Davis DR grading: 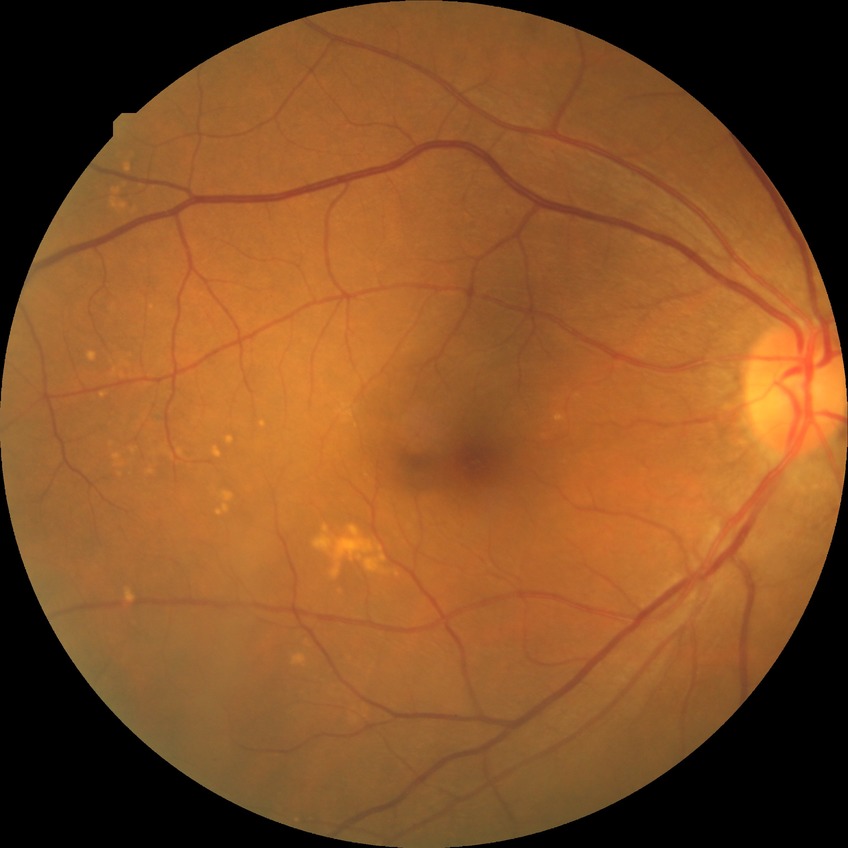 Diabetic retinopathy severity: no diabetic retinopathy.